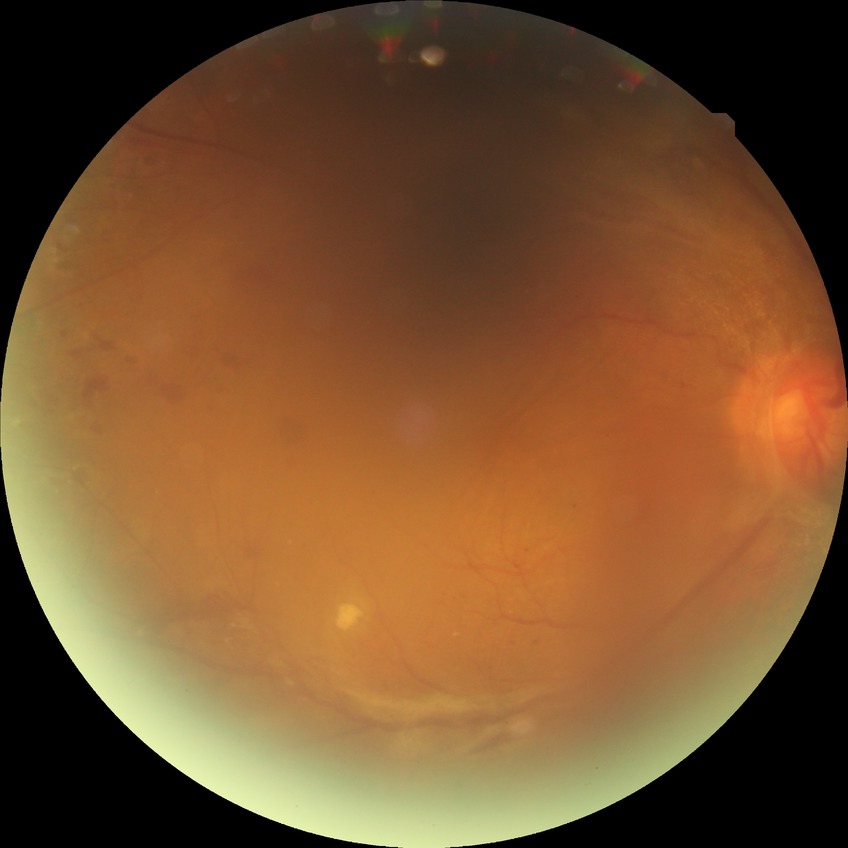
Modified Davis grade is PDR.